Camera: NIDEK AFC-230 · nonmydriatic fundus photograph · posterior pole color fundus photograph.
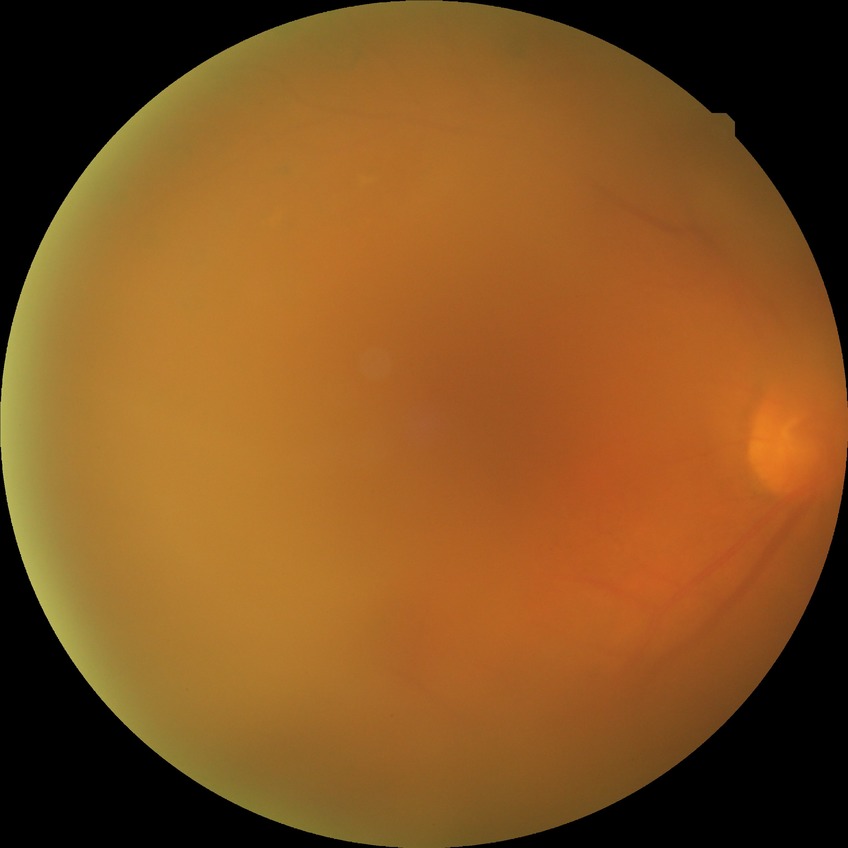

Davis stage is PDR.